NIDEK AFC-230 · 848x848px · no pharmacologic dilation:
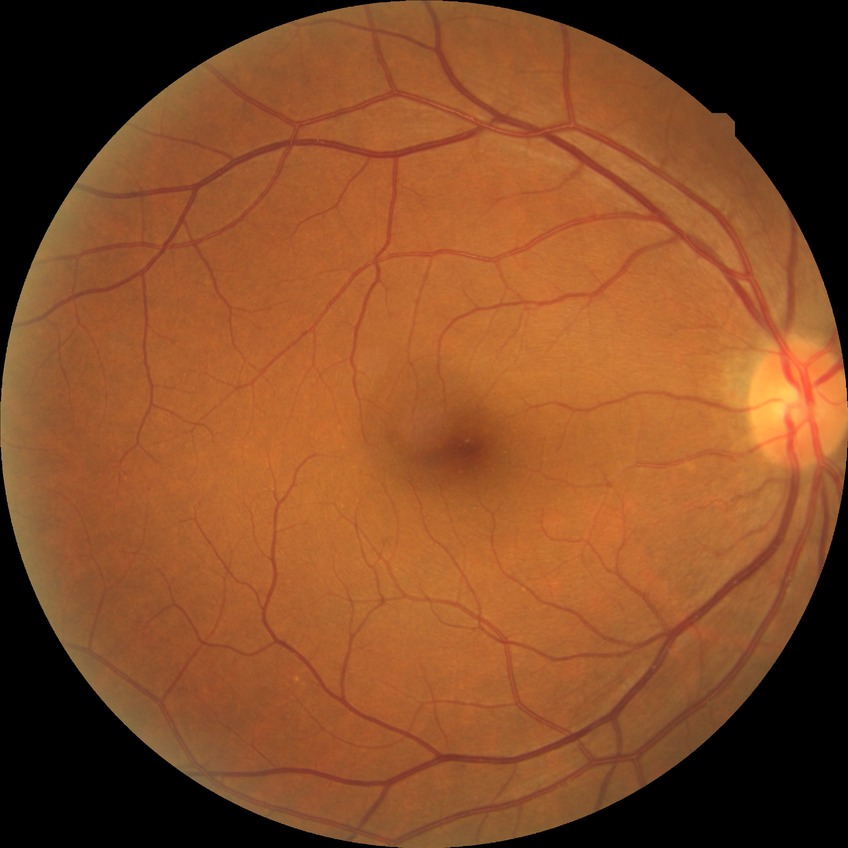 diabetic retinopathy (DR)@no diabetic retinopathy (NDR).